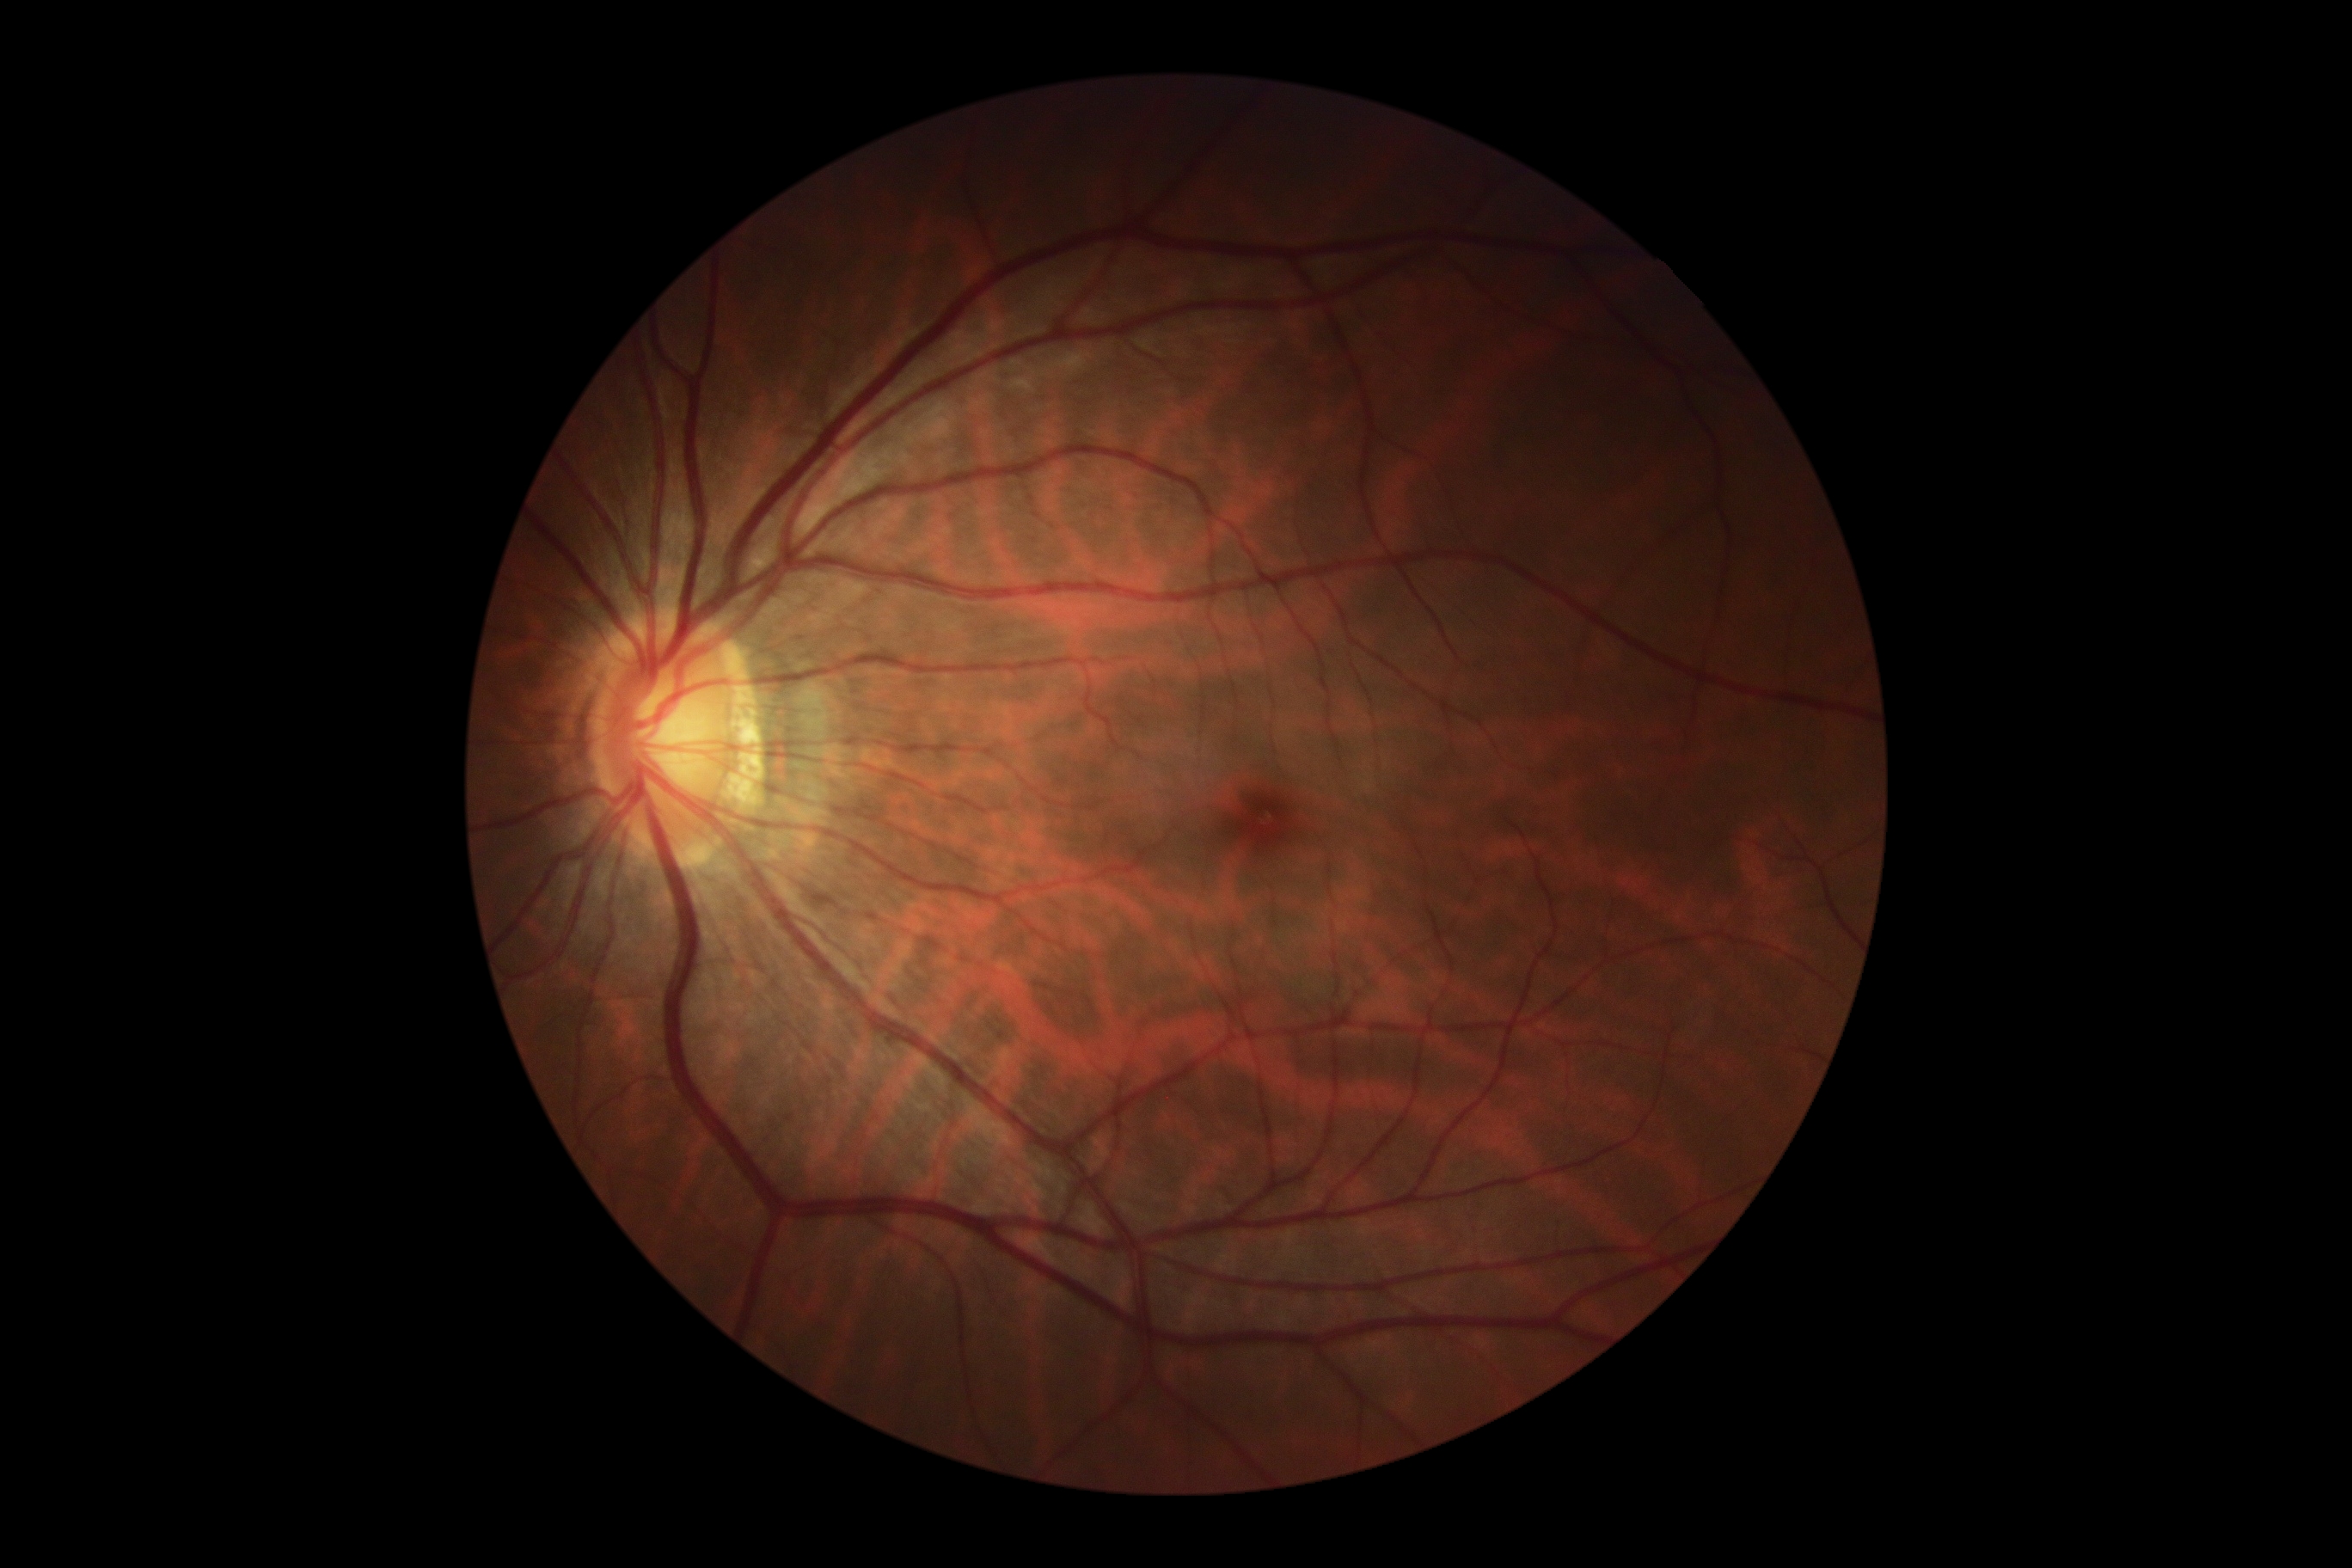

No DR findings.
DR grade: 0 (no apparent retinopathy).